DR severity per modified Davis staging:
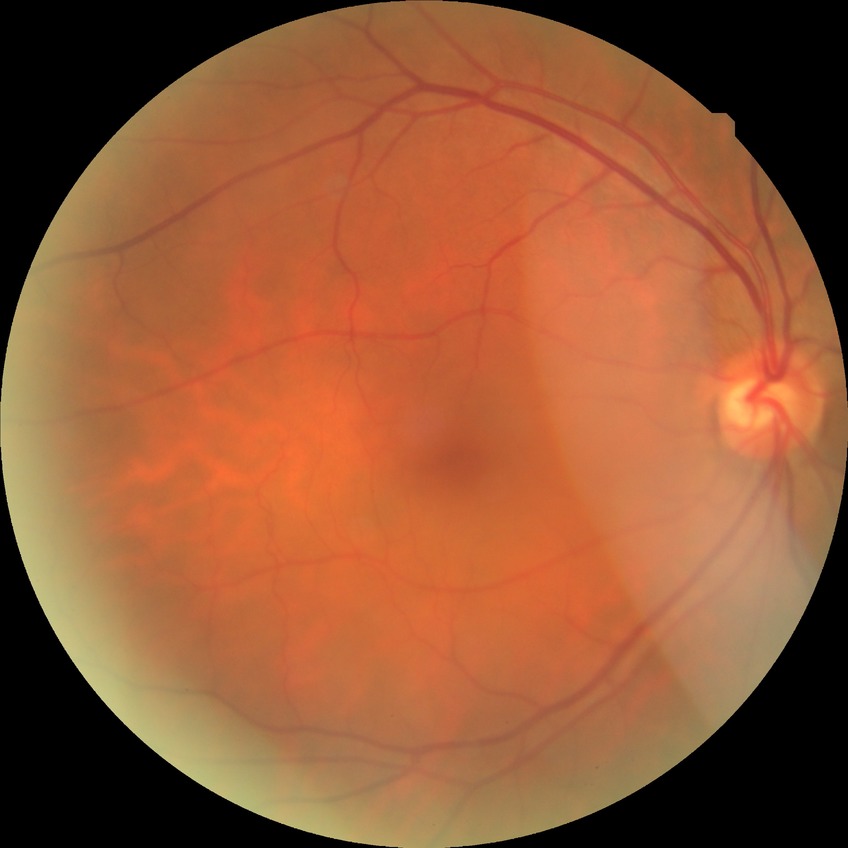
Modified Davis classification is no diabetic retinopathy.